Captured with the Natus RetCam Envision (130° field of view). Pediatric wide-field fundus photograph — 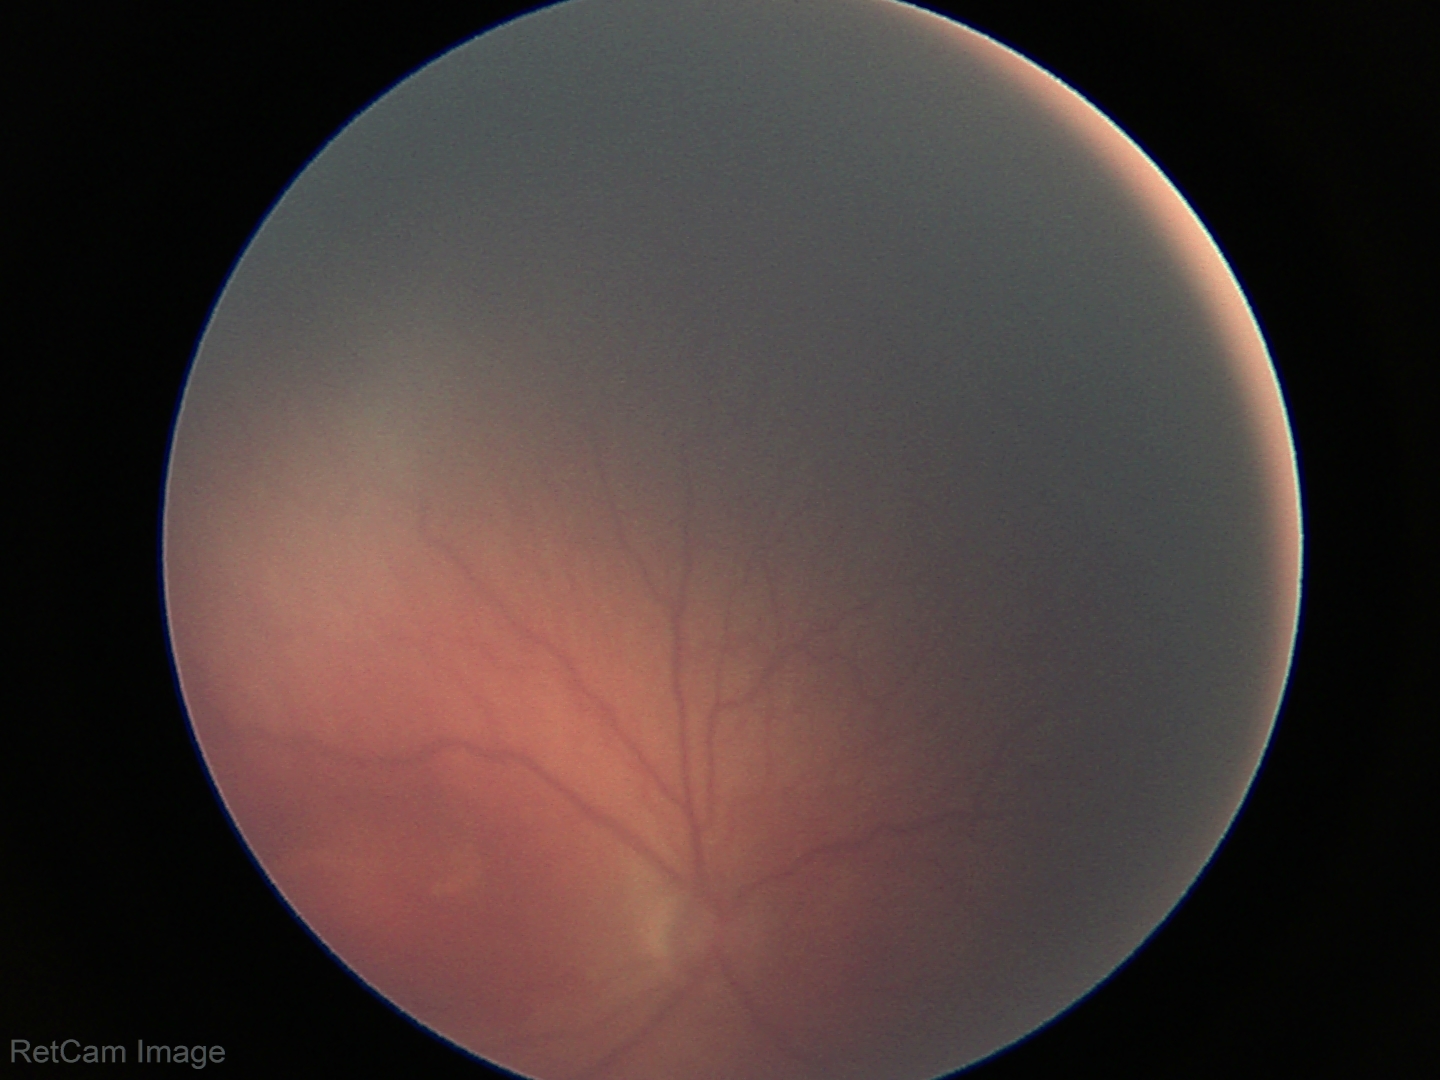

Q: What was the screening finding?
A: ROP stage 2 — ridge with height and width at the demarcation line
Q: Plus disease status?
A: no plus disease